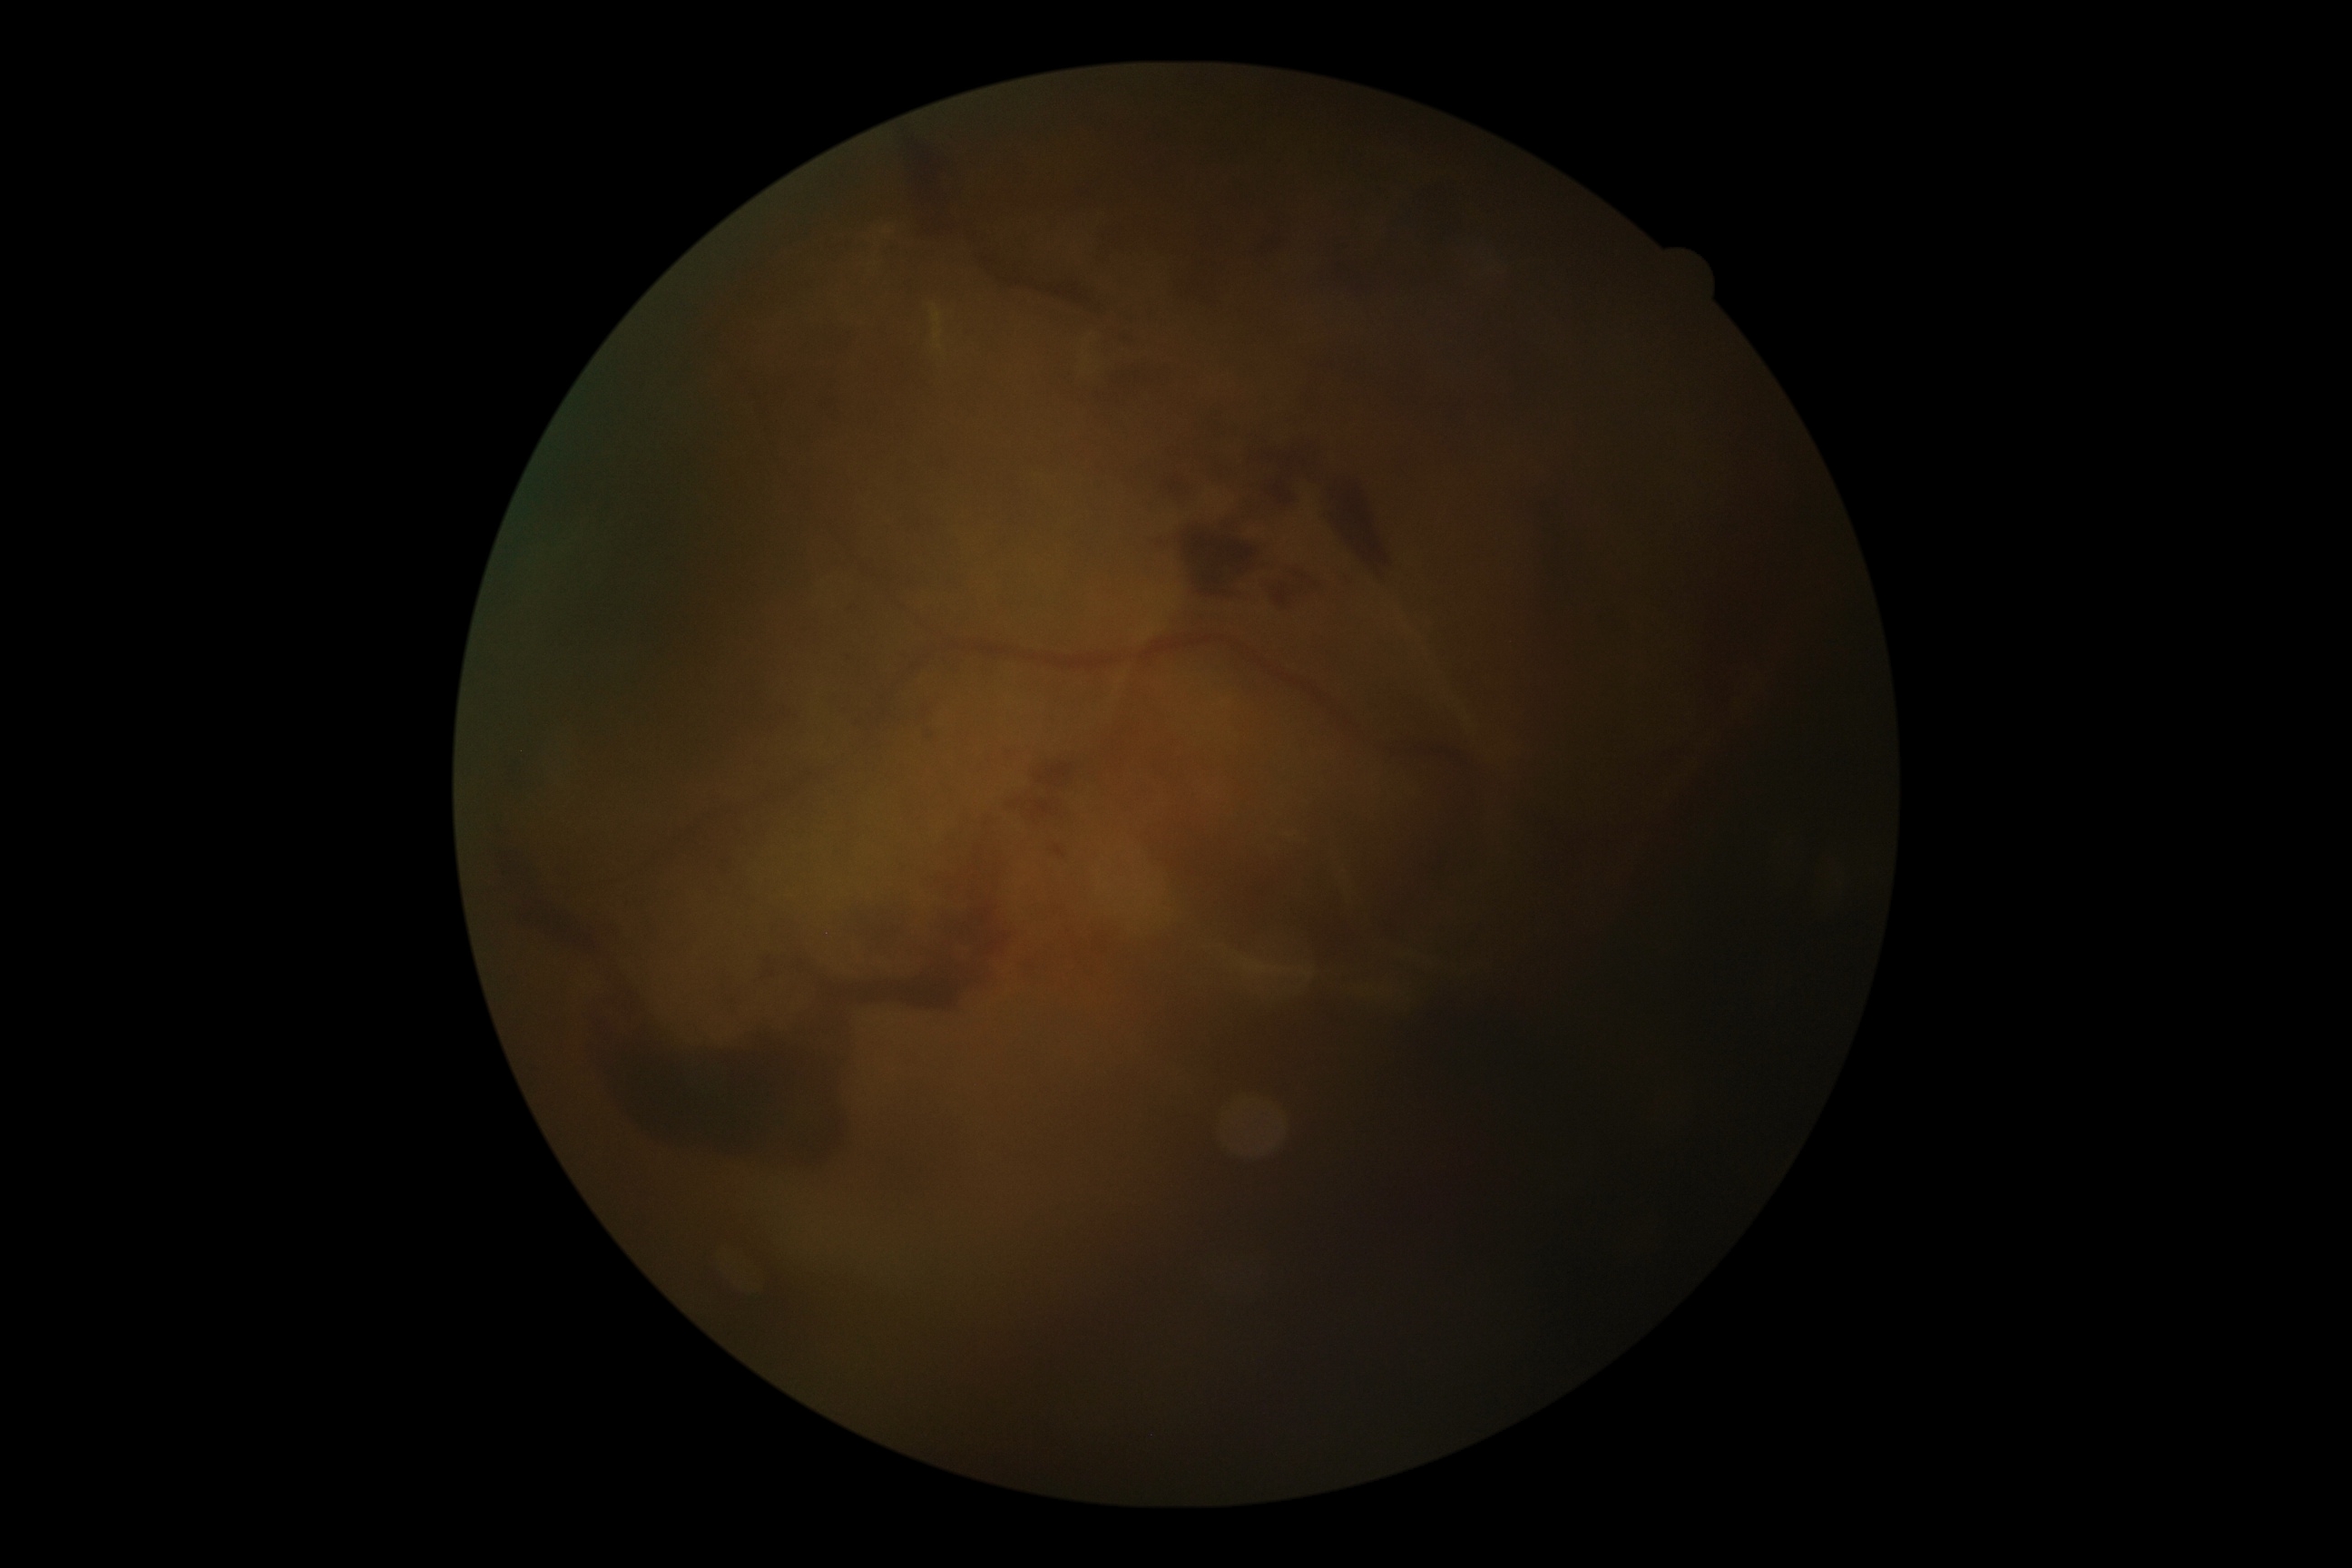
{"dr_grade": "PDR (4)"}